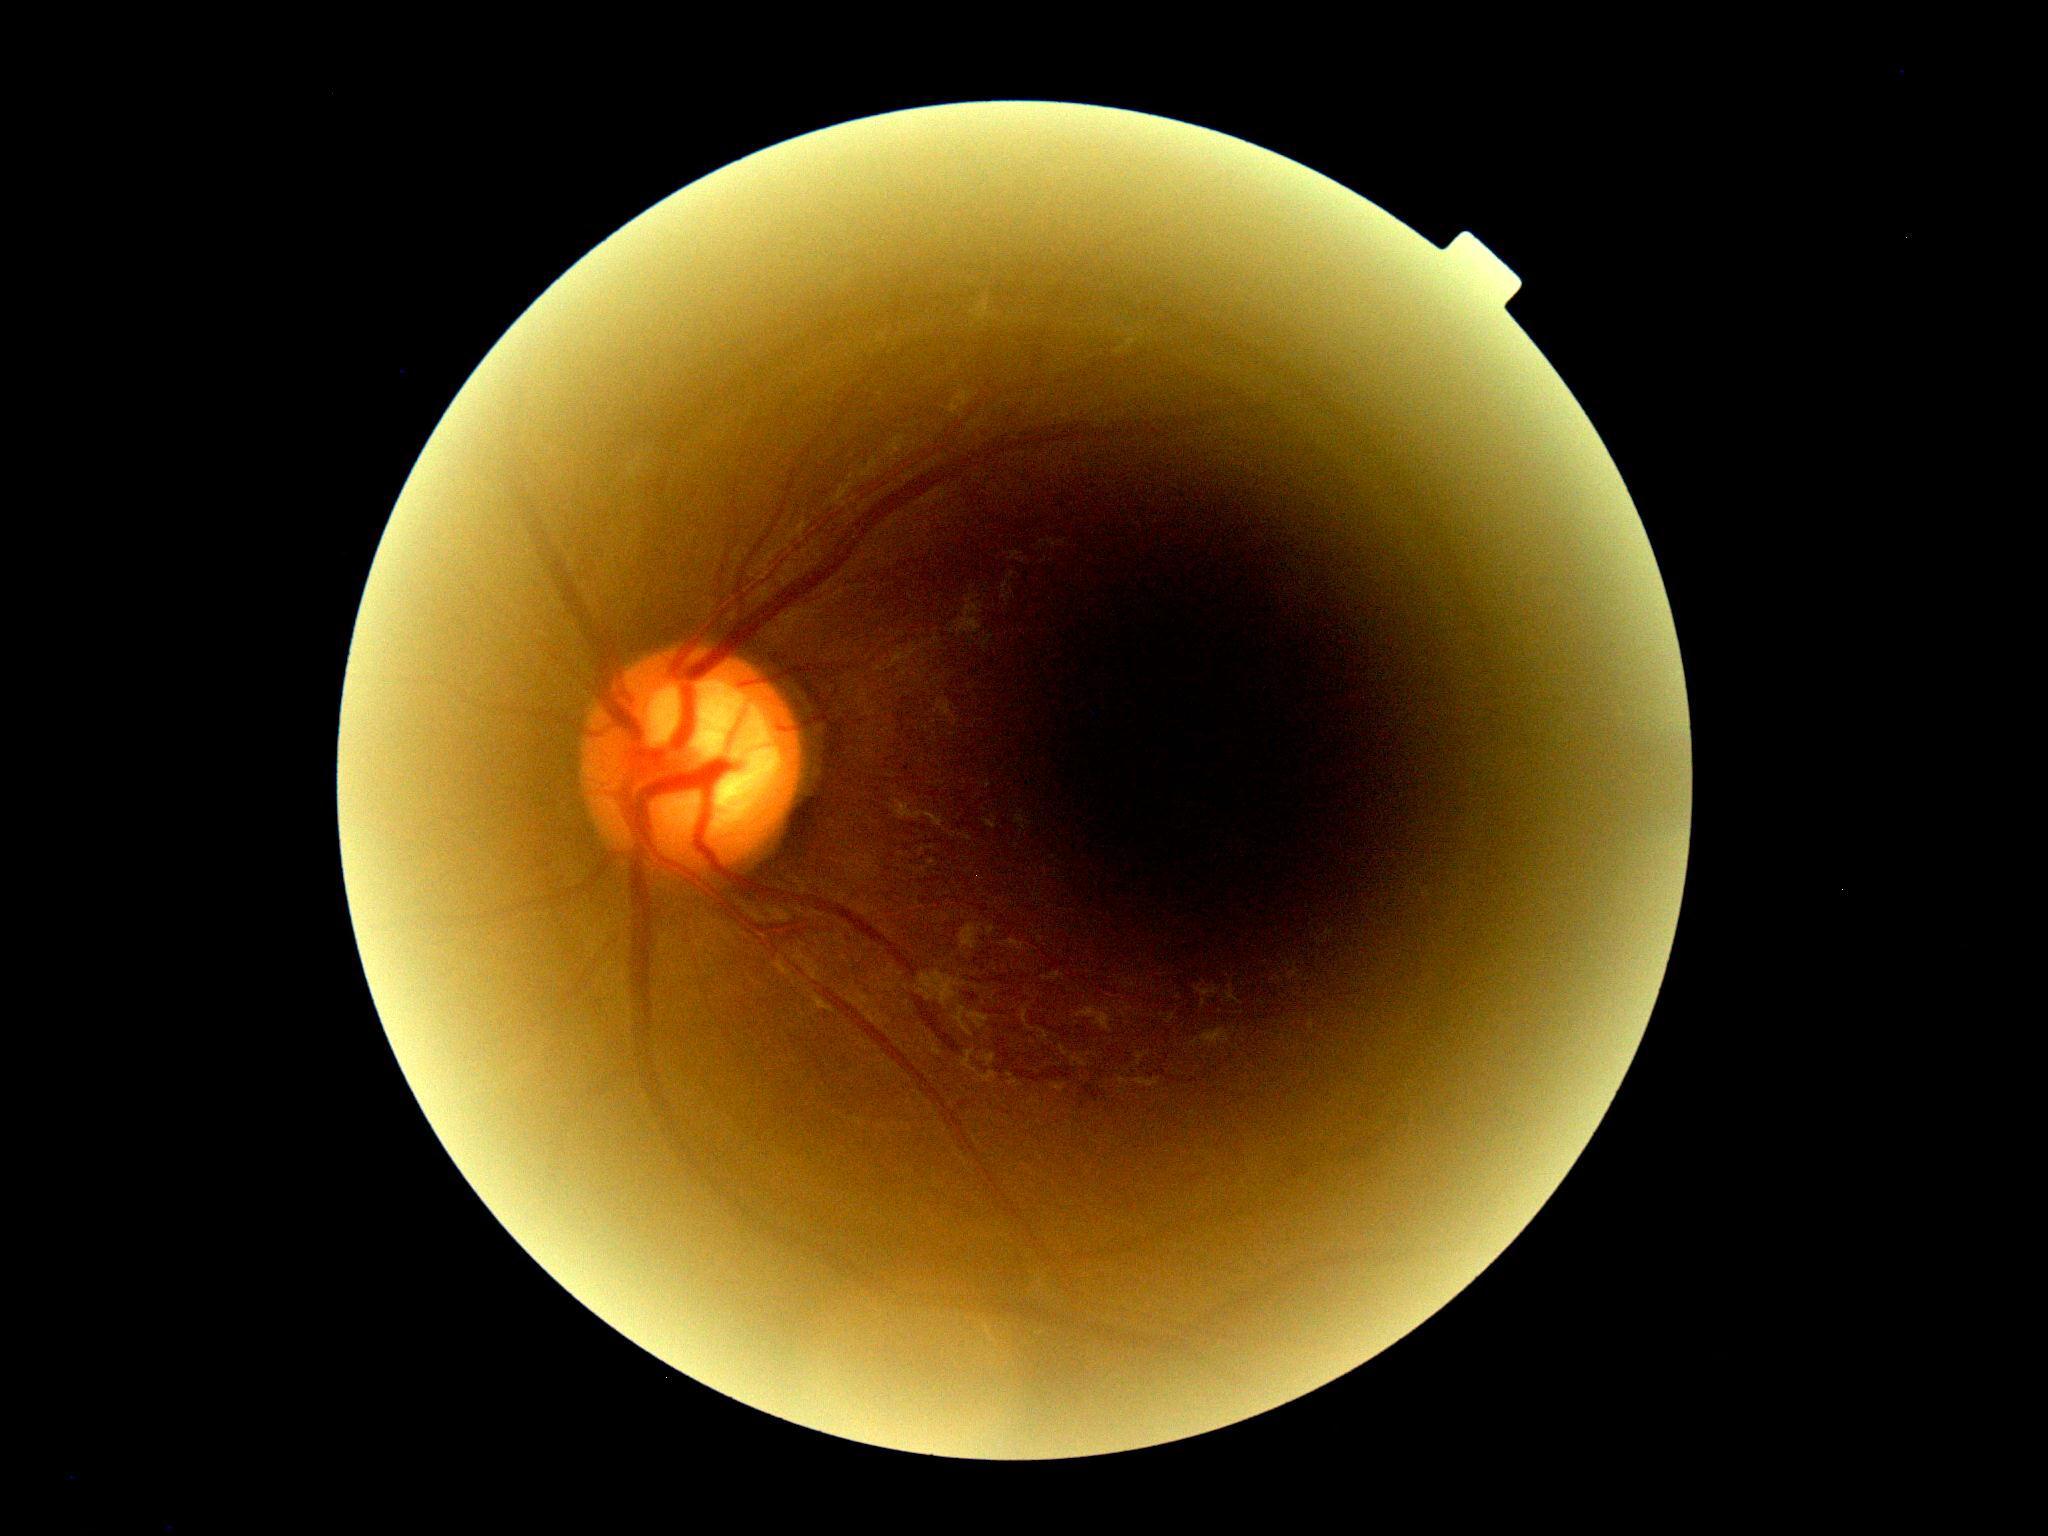

DR: ungradable due to poor image quality.
Quality too poor to assess for DR.